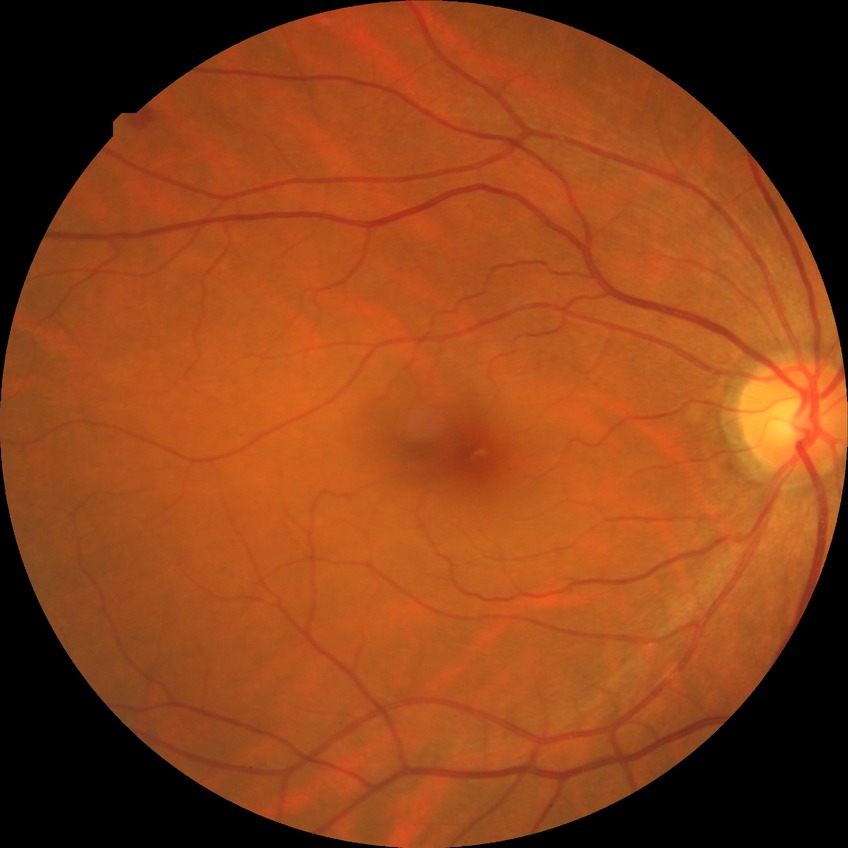 • diabetic retinopathy stage — simple diabetic retinopathy